CFP: 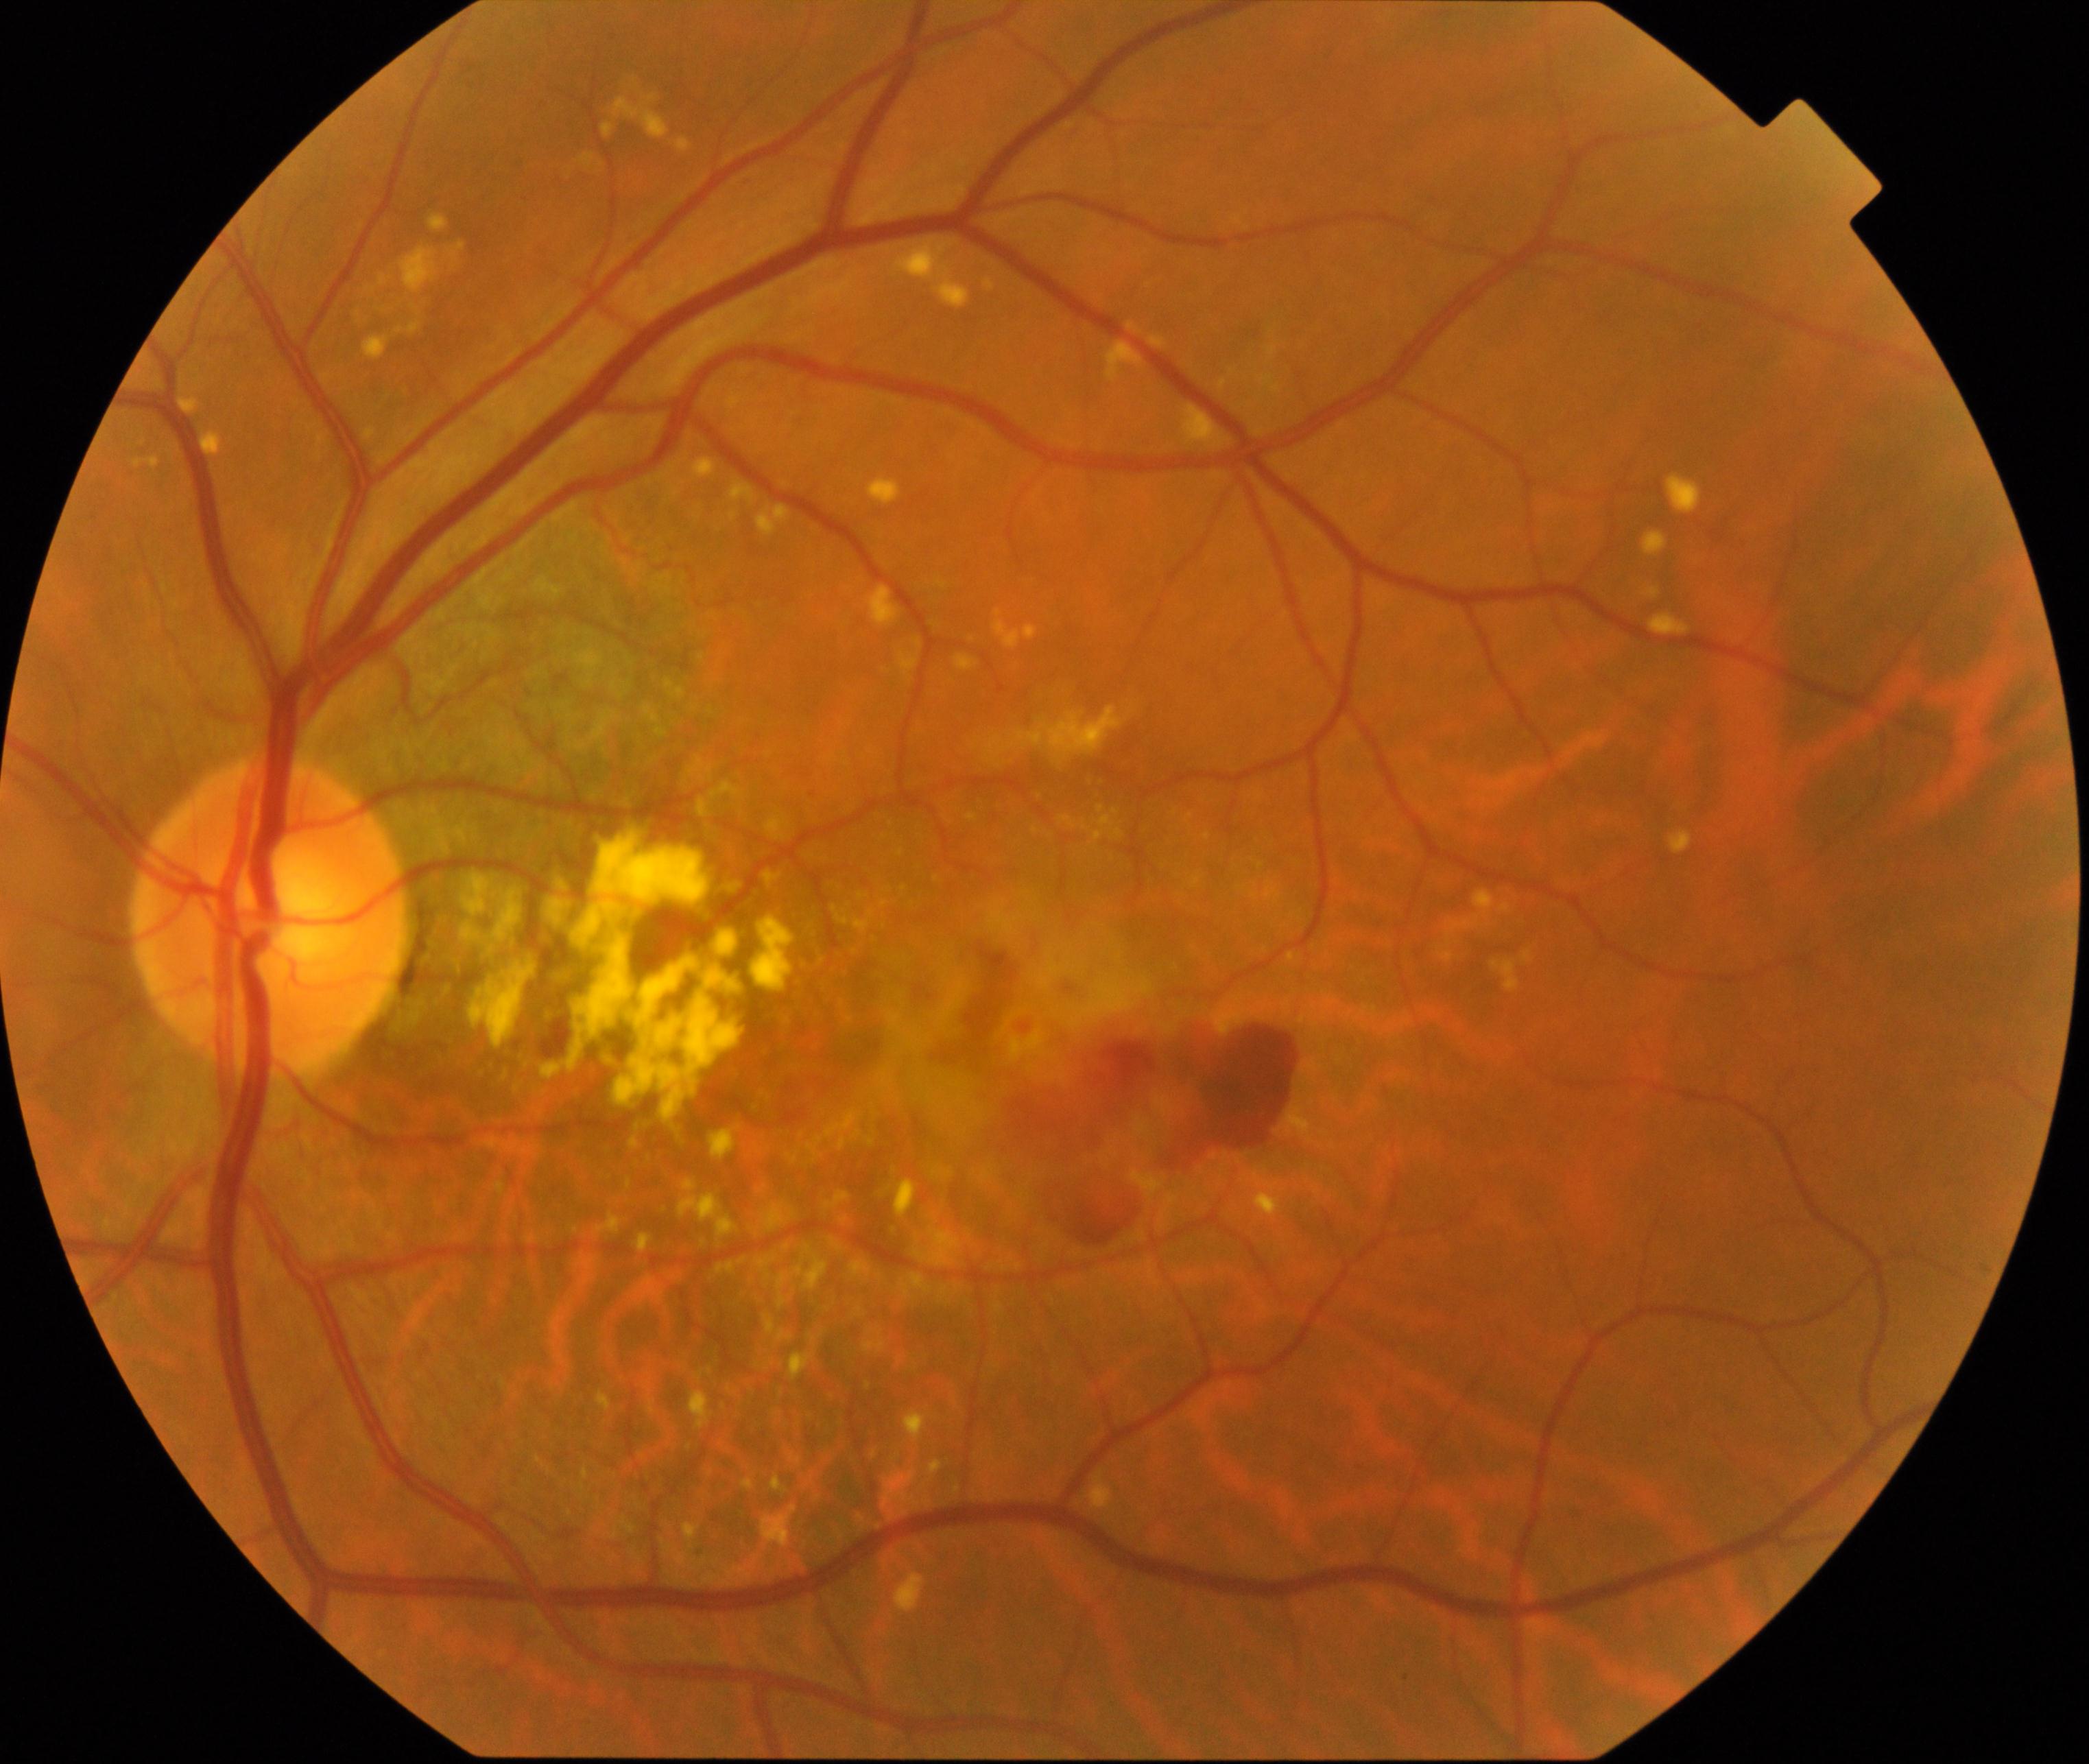
Diagnosis: maculopathy.